Topcon TRC-50DX, dilated-pupil acquisition, CFP, 50° field of view: 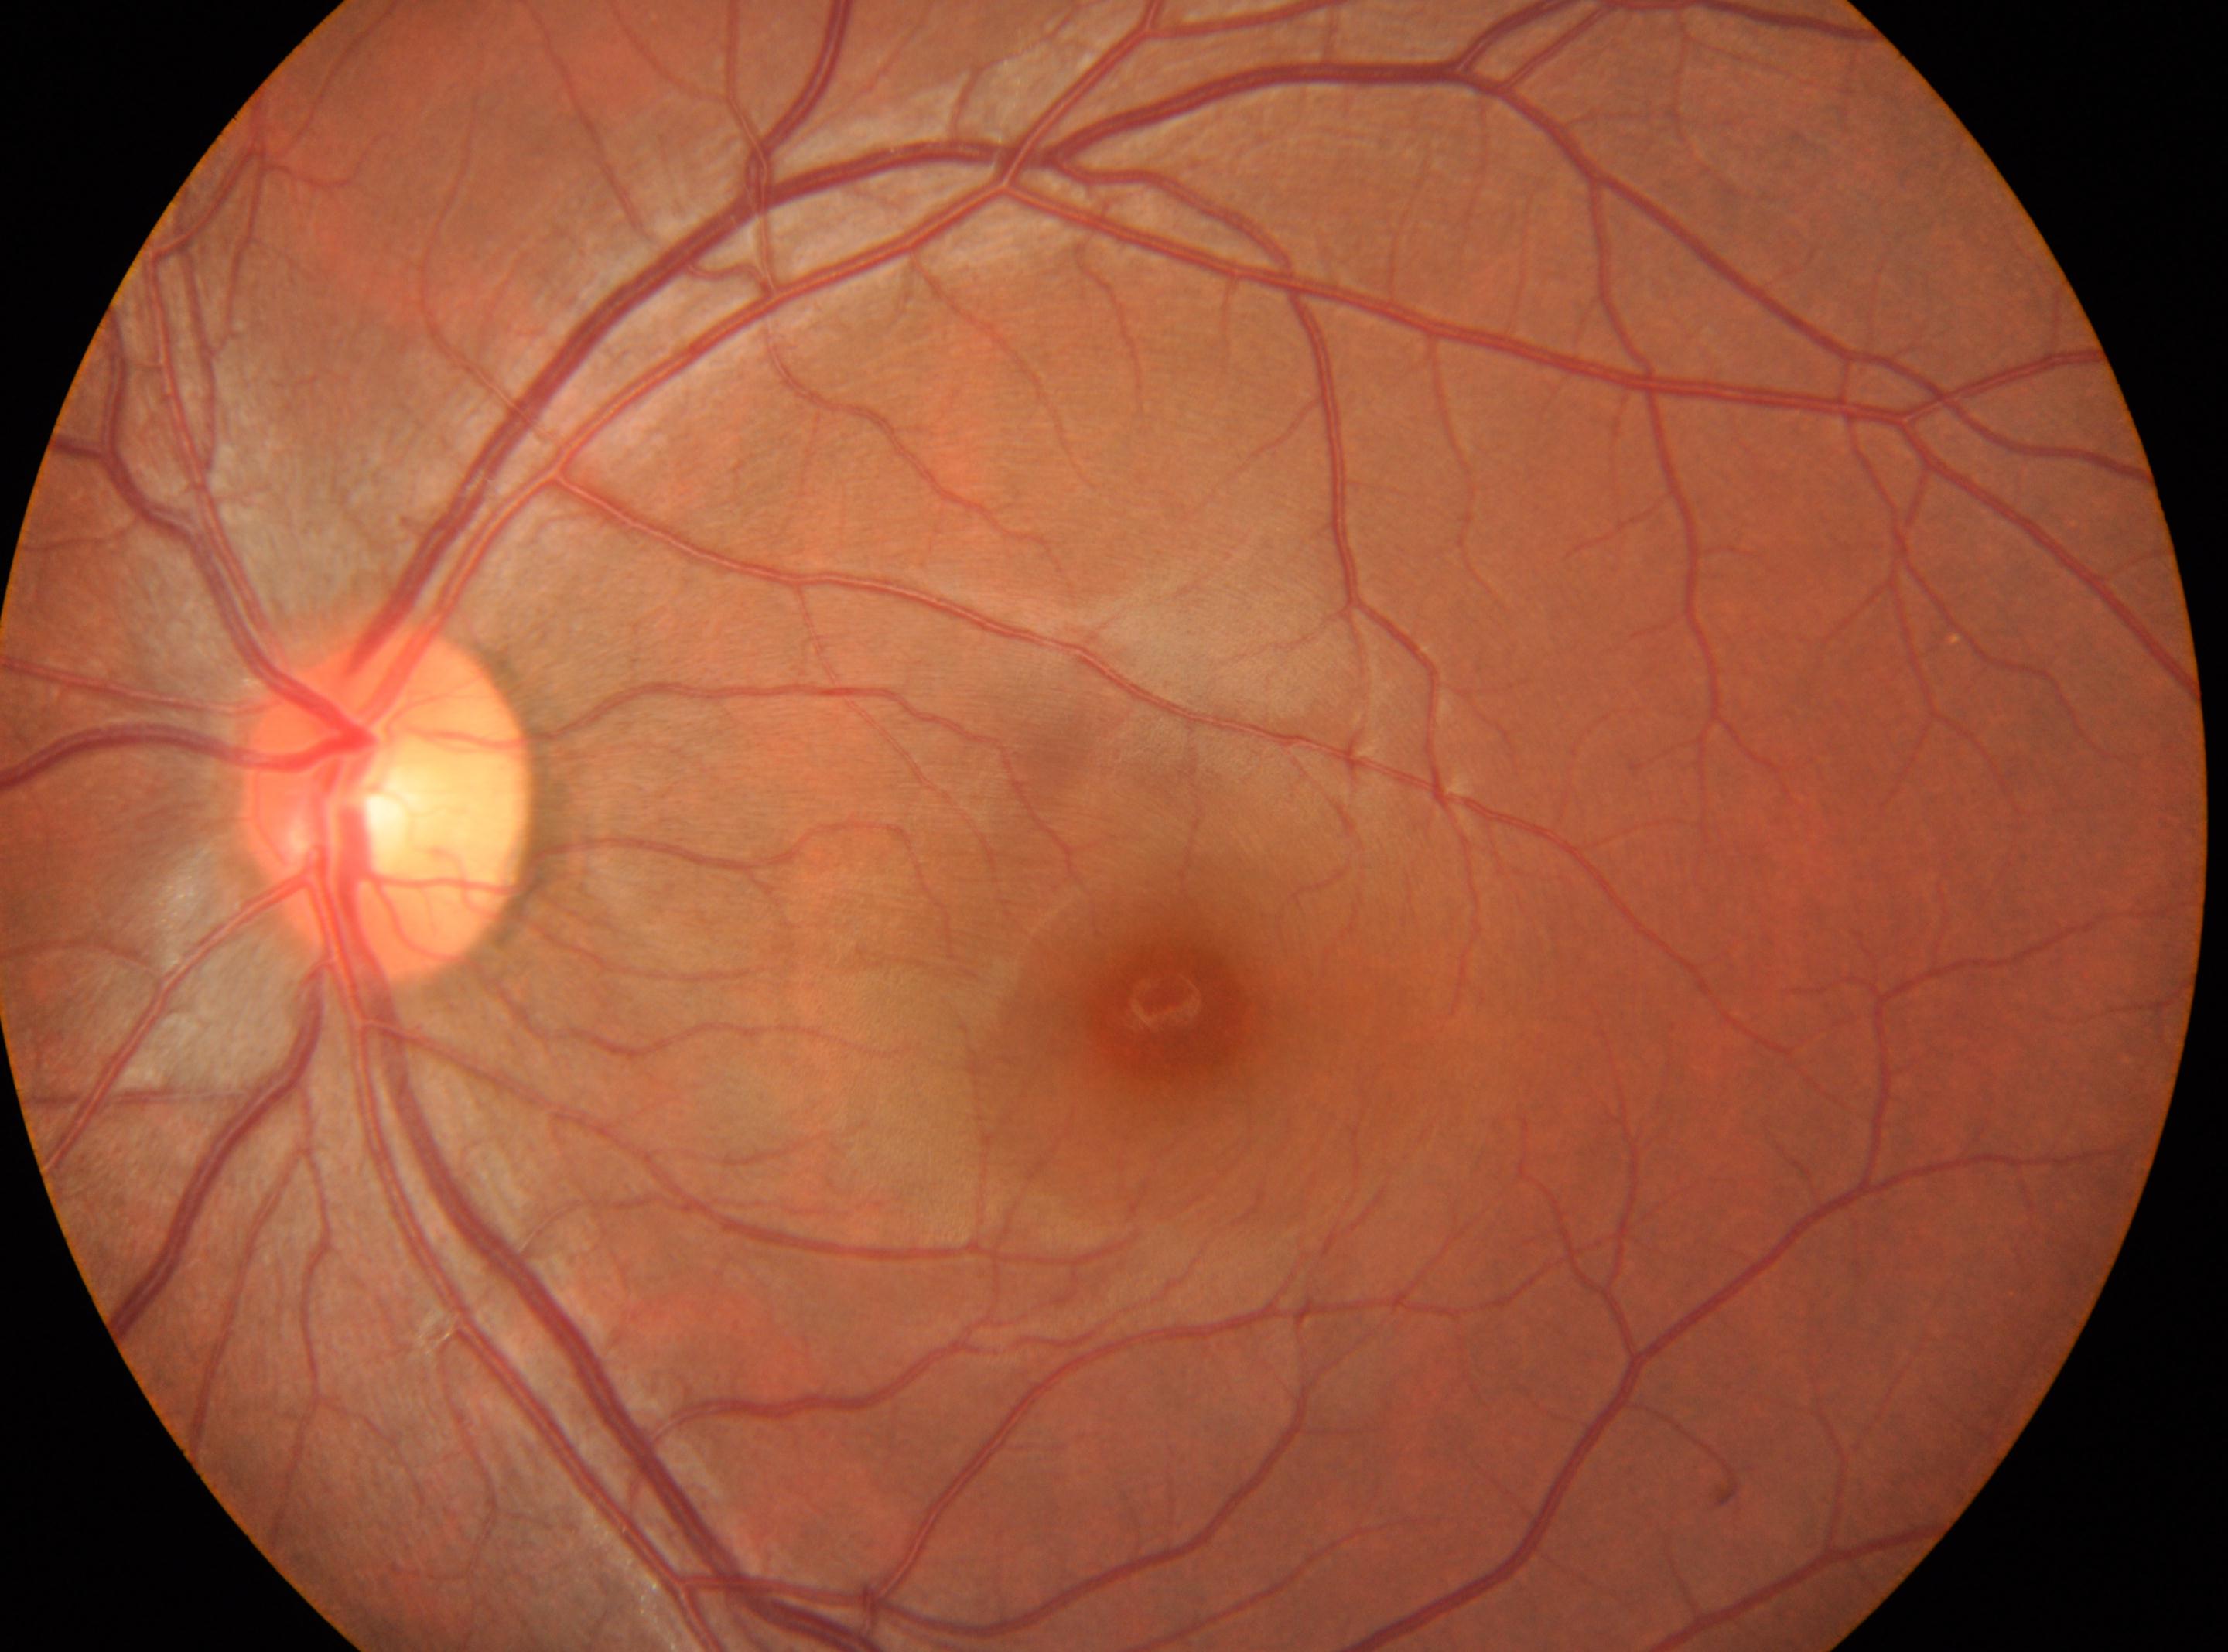

Macula center located at (1179, 1005).
Optic disc center: (387, 803).
Diabetic retinopathy: grade 0 (no apparent retinopathy).
Eye: the left eye.